Fundus photo, camera: Topcon TRC-50DX, pupil-dilated
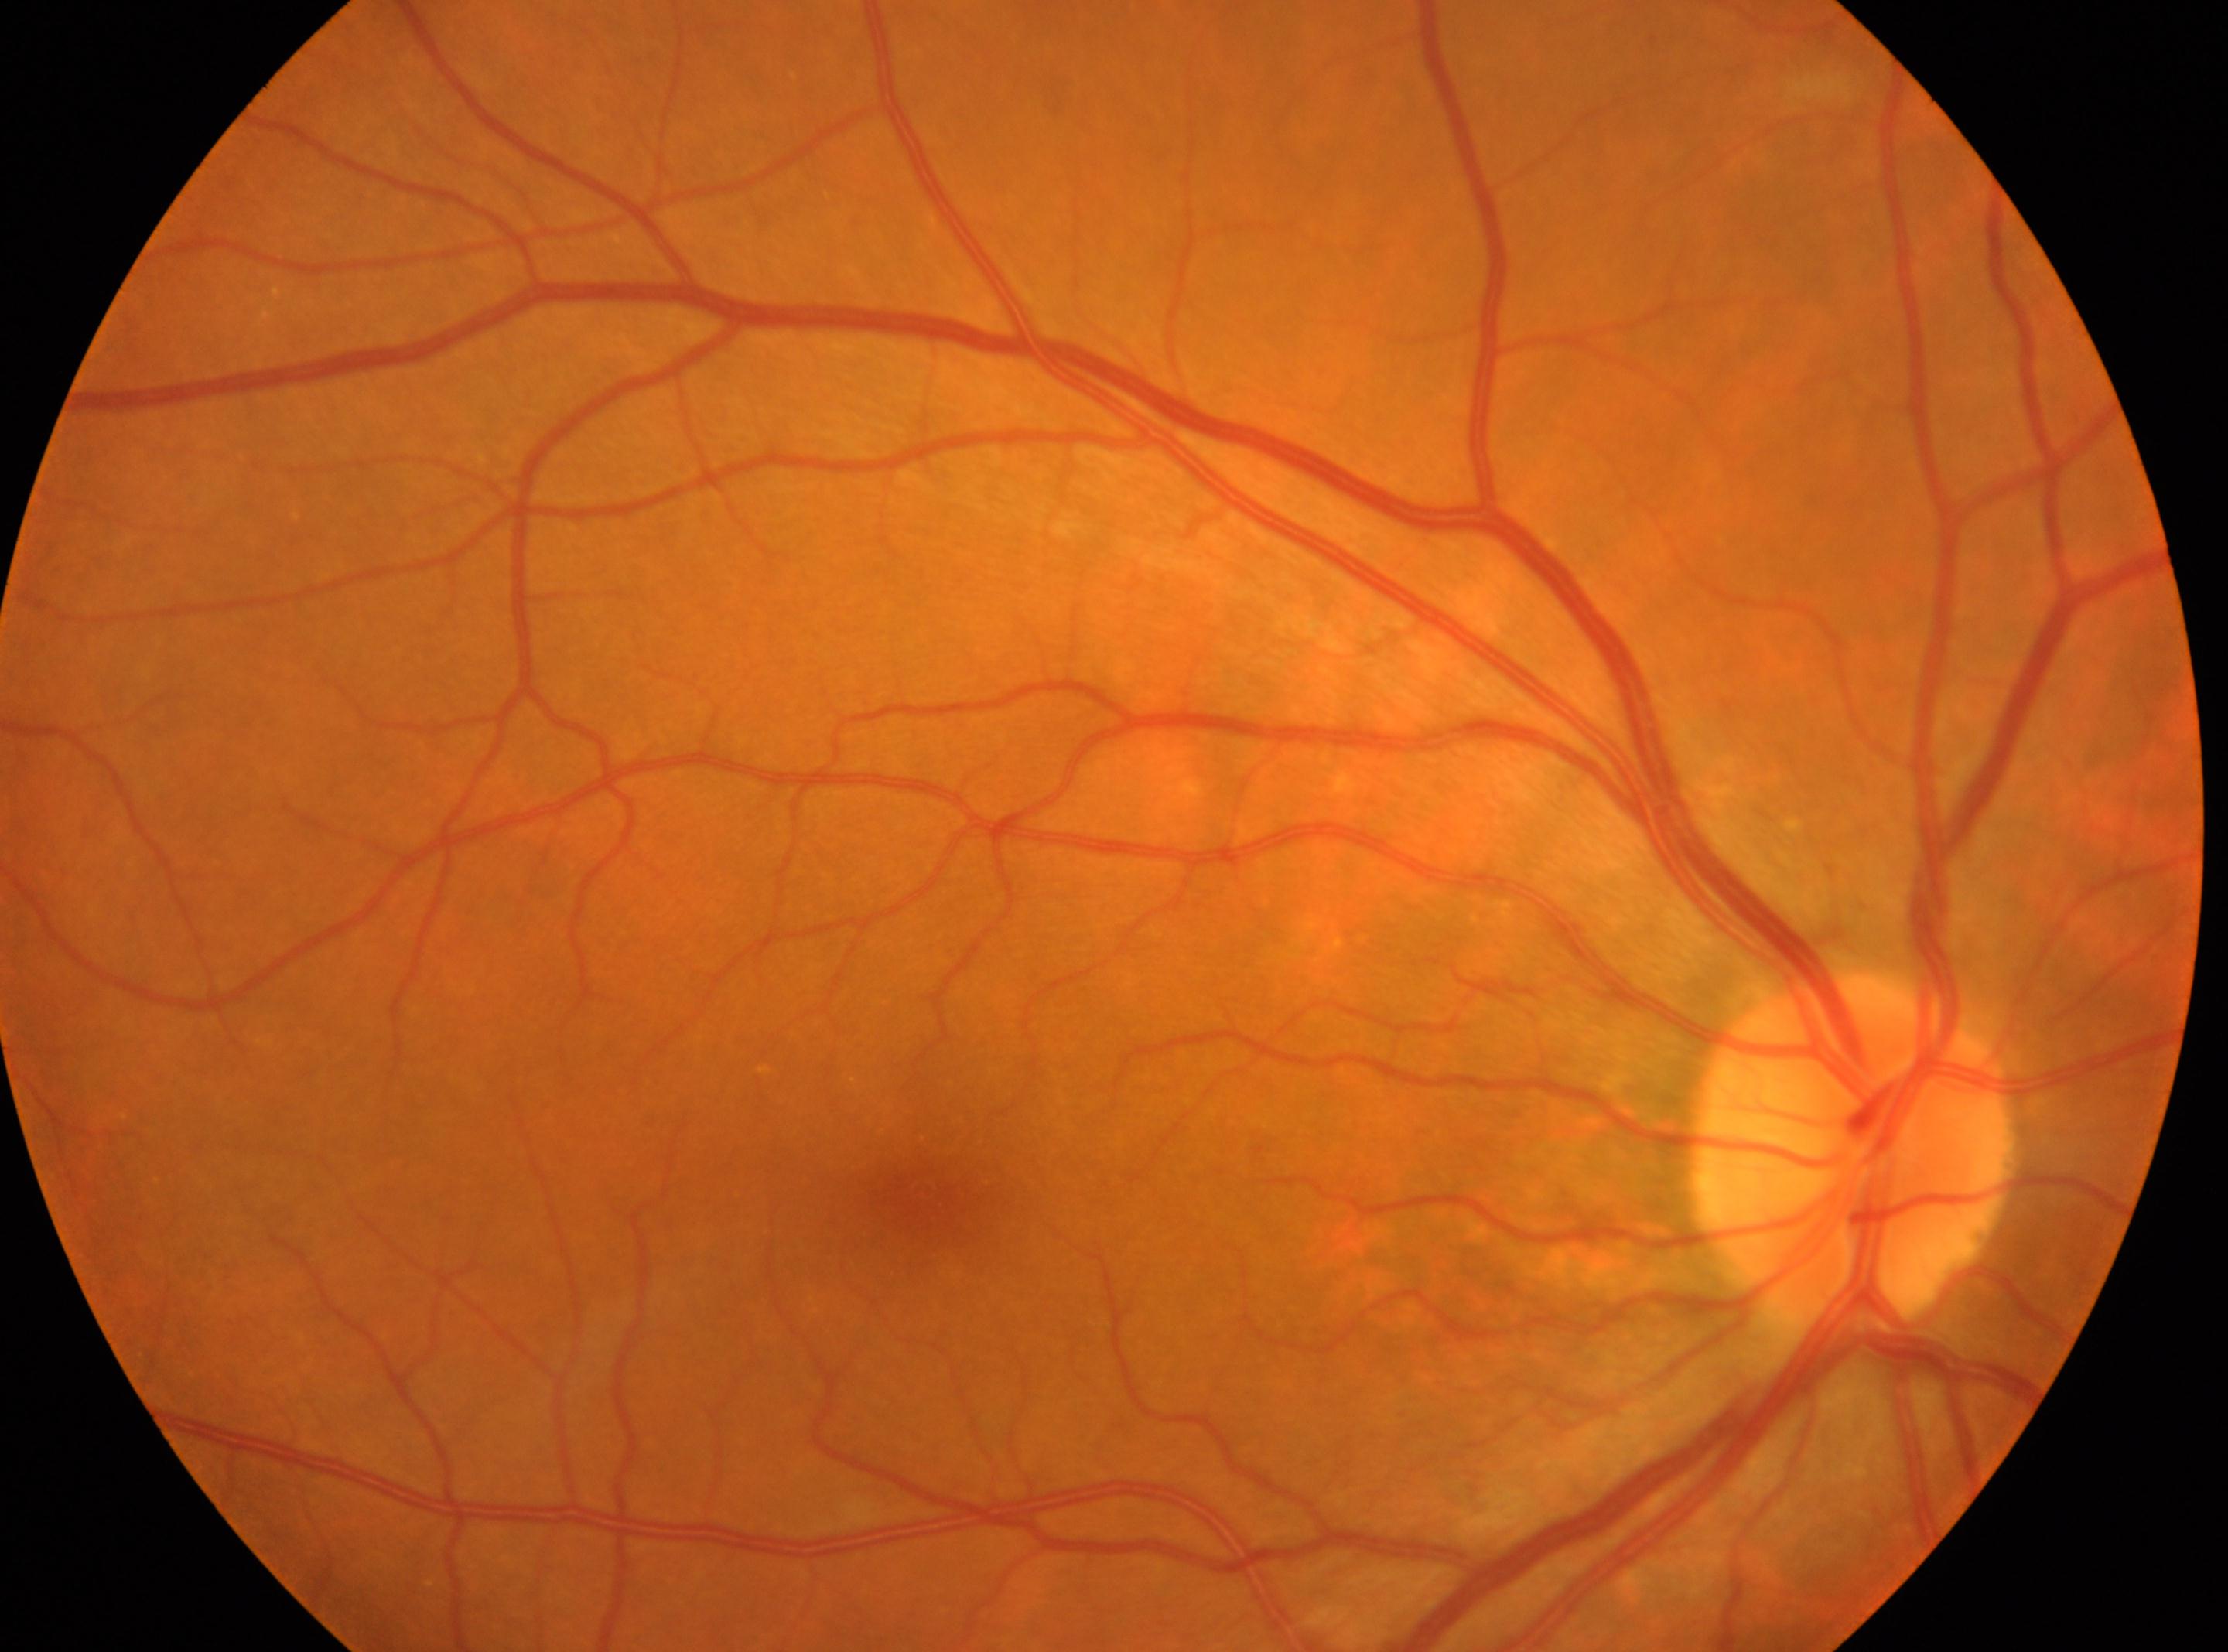
Fovea centralis located at 924, 1193.
Imaged eye: oculus dexter.
DR grade is 0 (no apparent retinopathy).
No signs of diabetic retinopathy.
Optic disc: 1852, 1151.